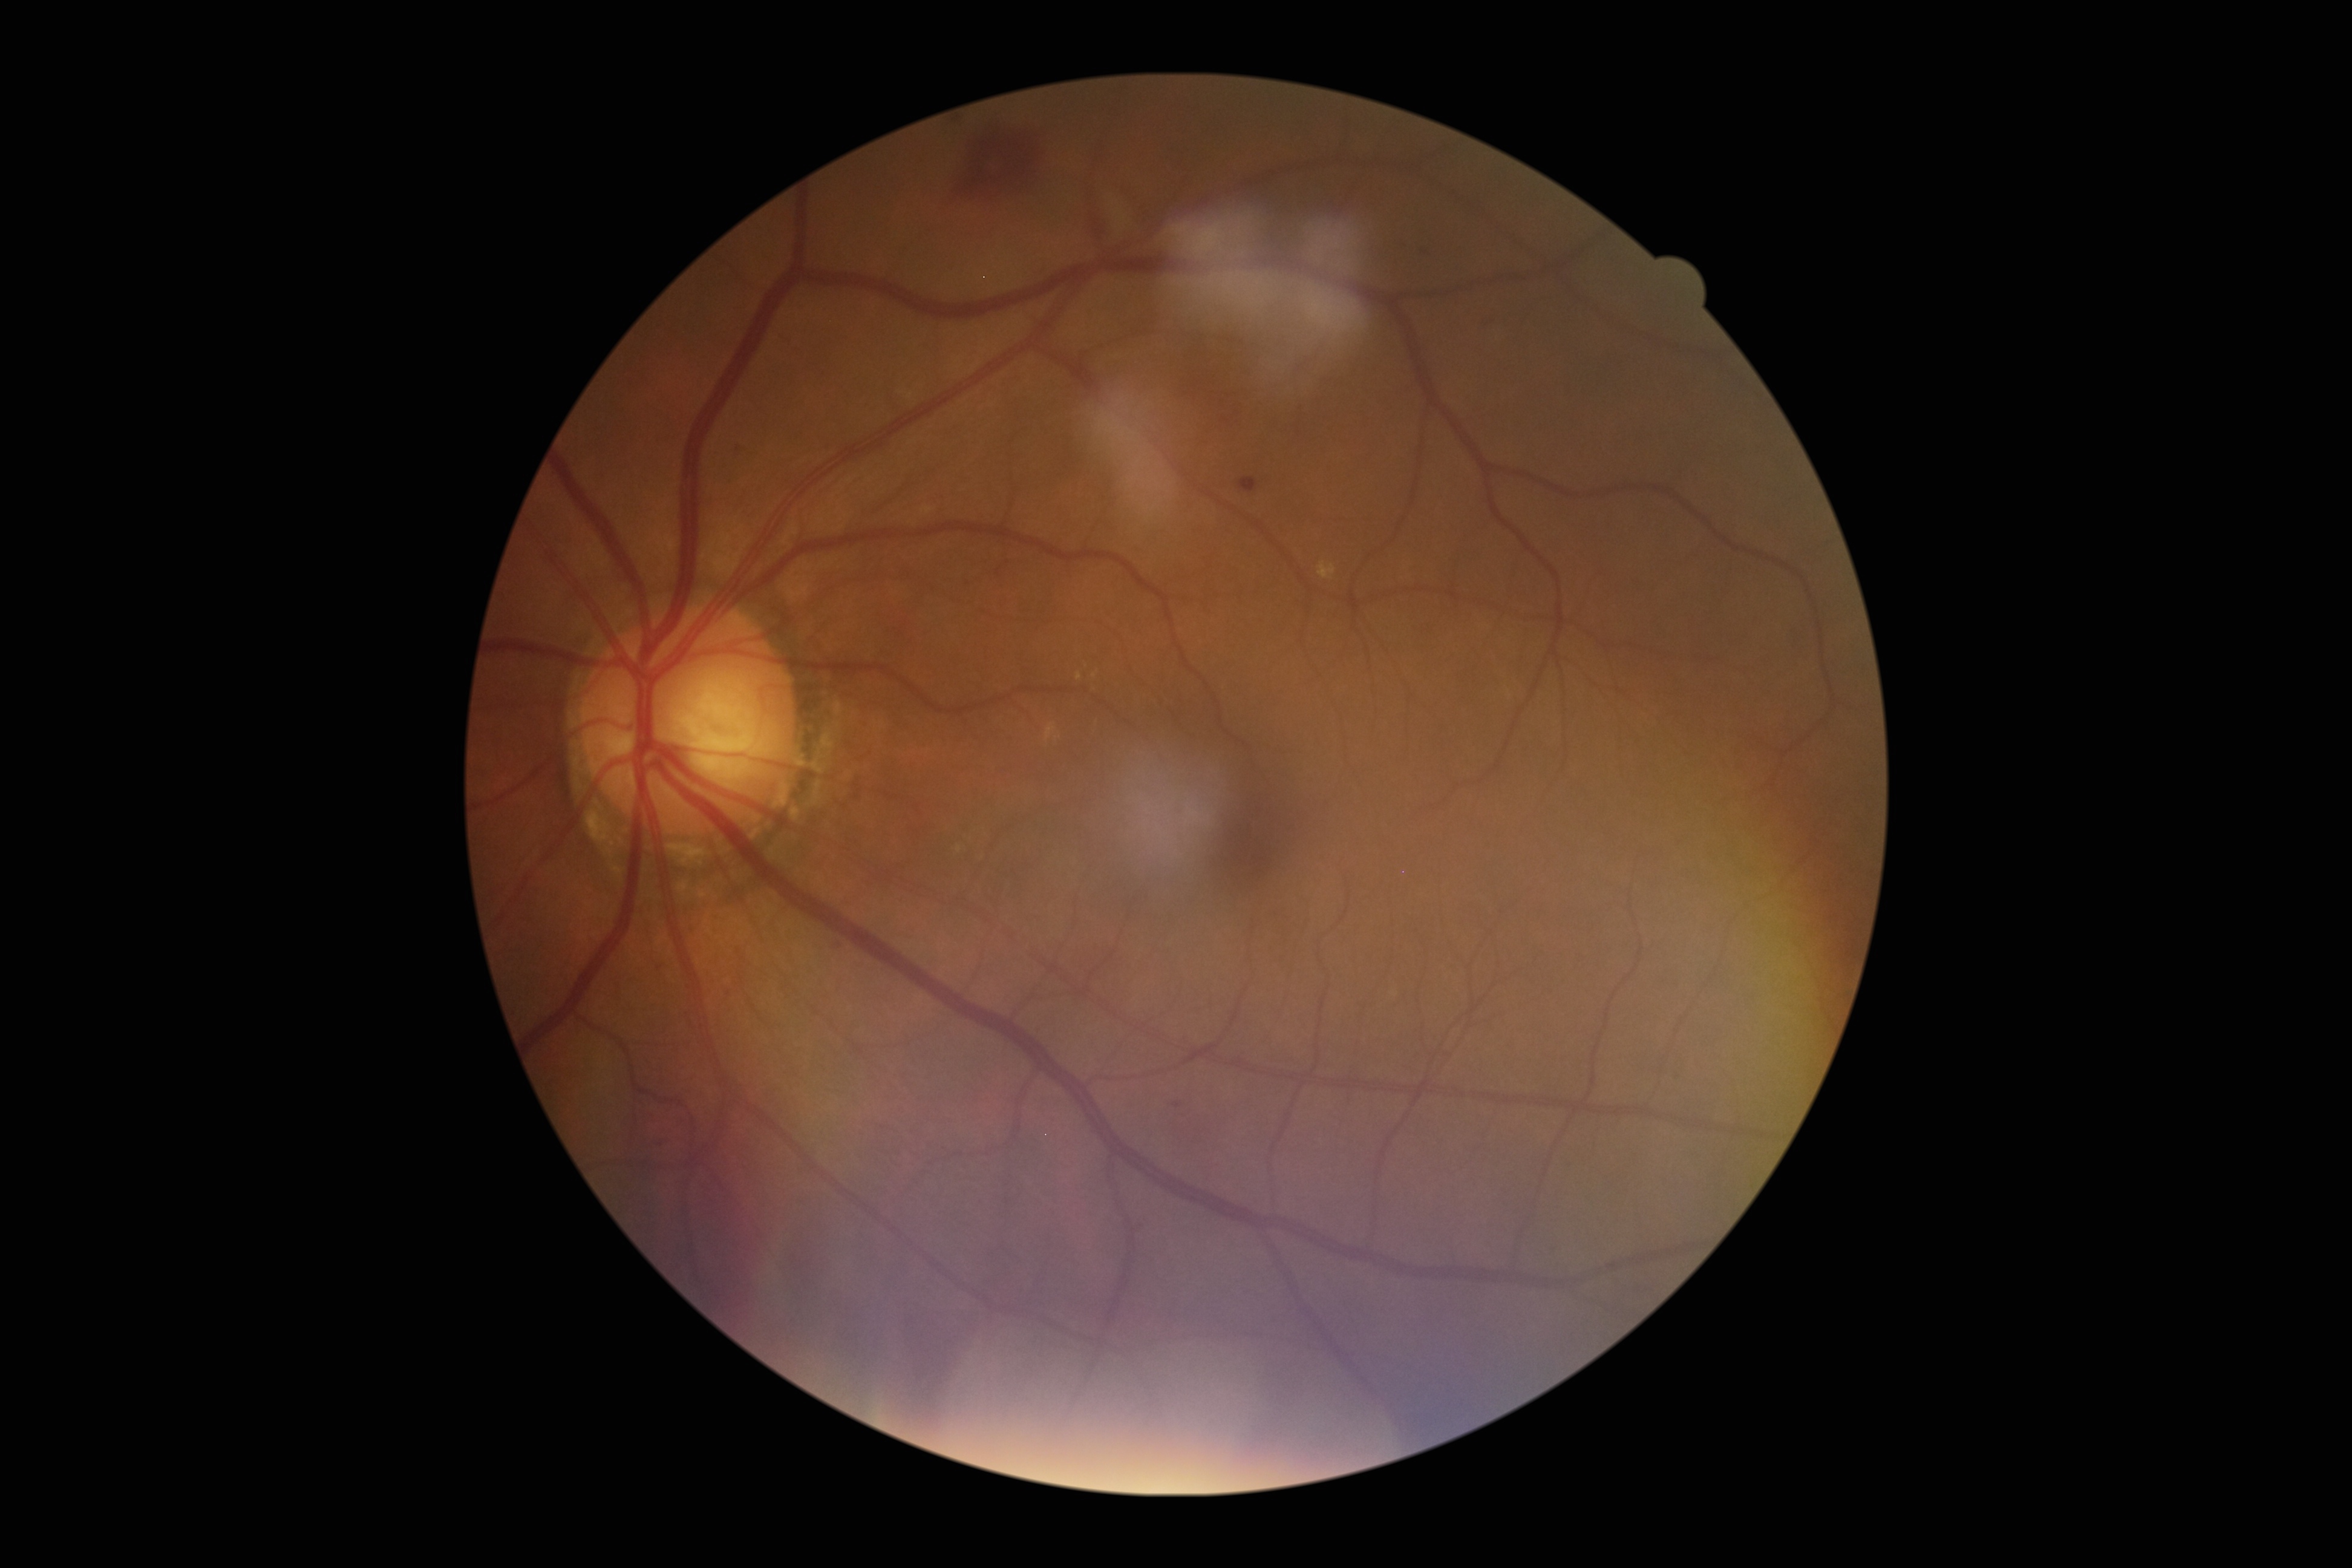

DR: moderate NPDR (grade 2).